No pharmacologic dilation. 848 x 848 pixels: 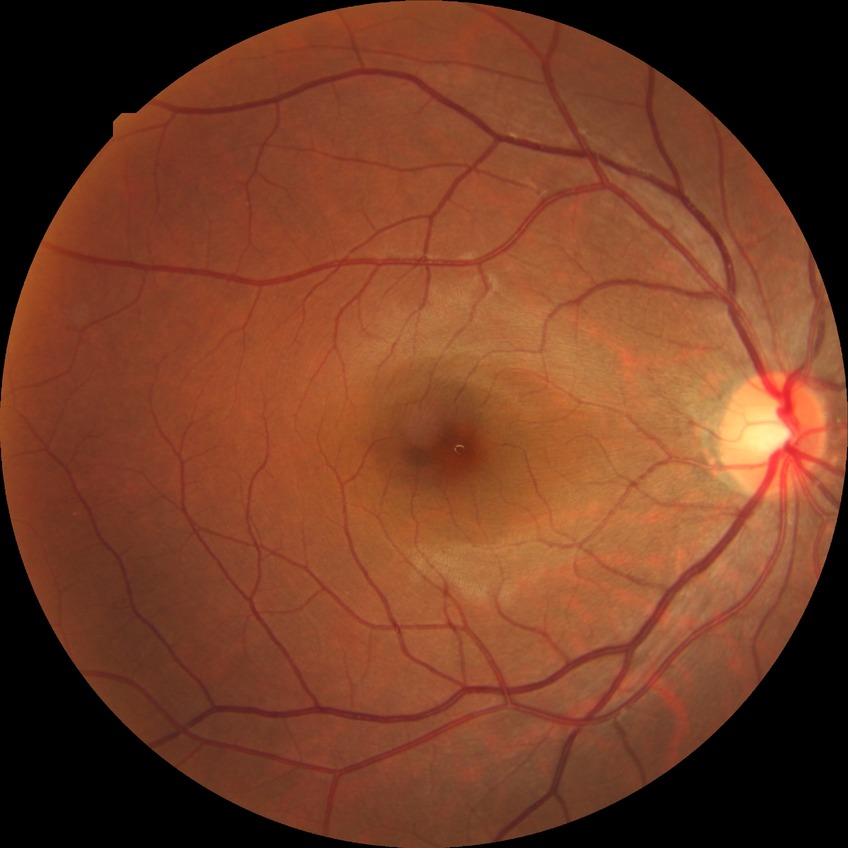 DR severity: NDR. No DR findings.